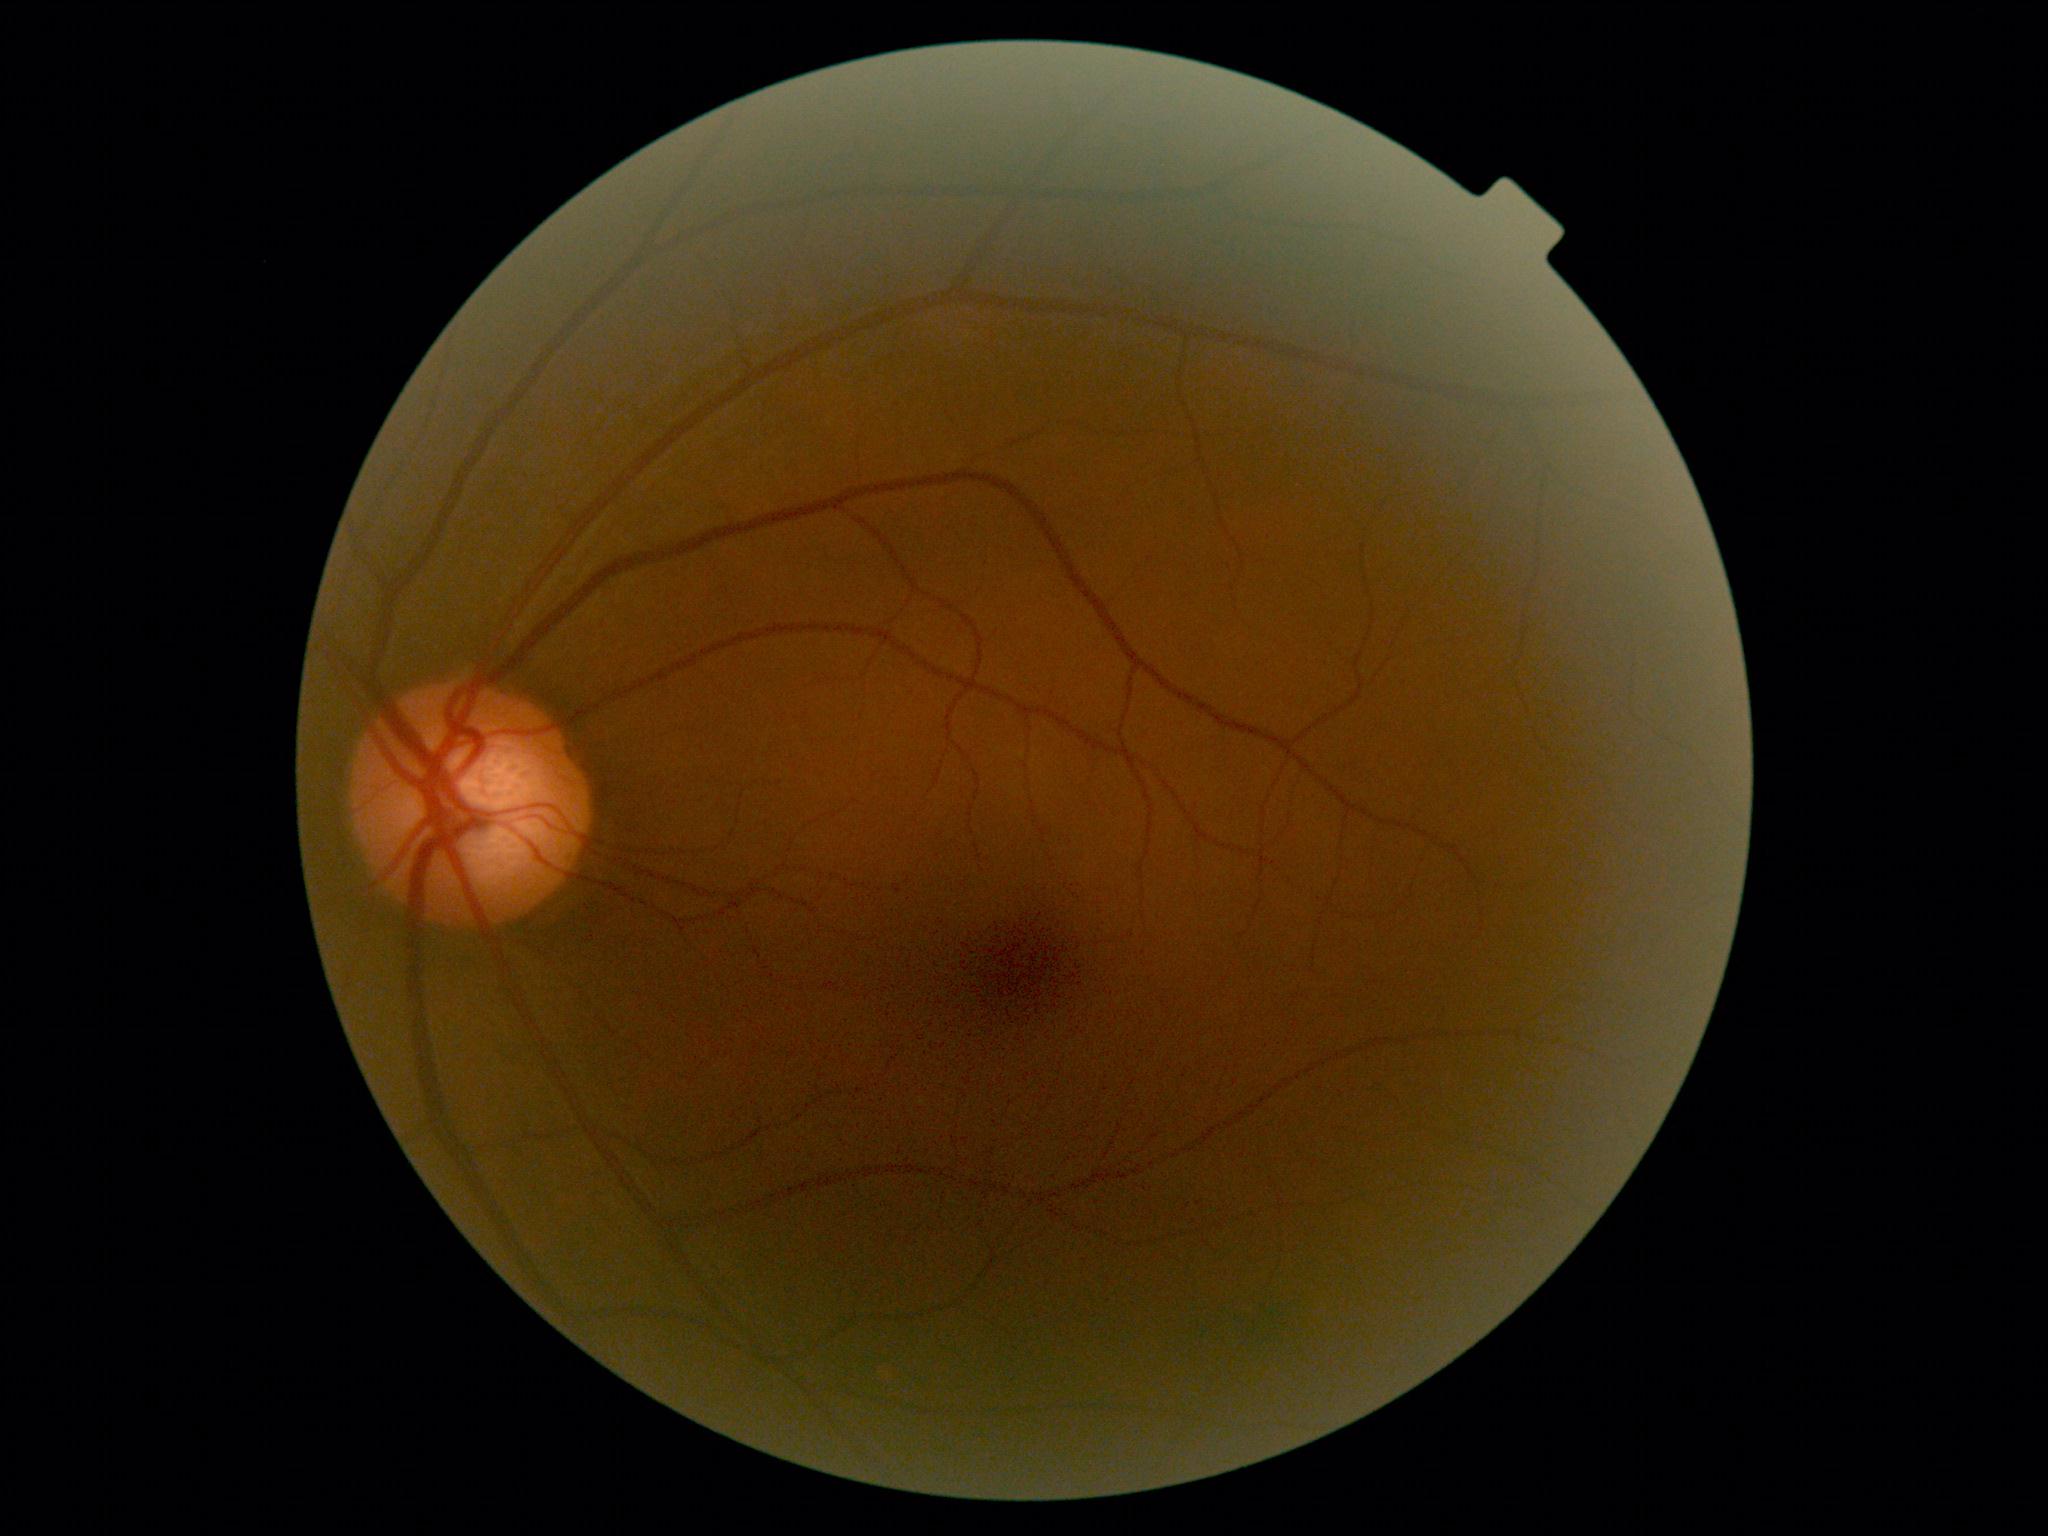
Diabetic retinopathy grade is no apparent diabetic retinopathy (0) — no visible signs of diabetic retinopathy. No signs of diabetic retinopathy.